Color fundus photograph
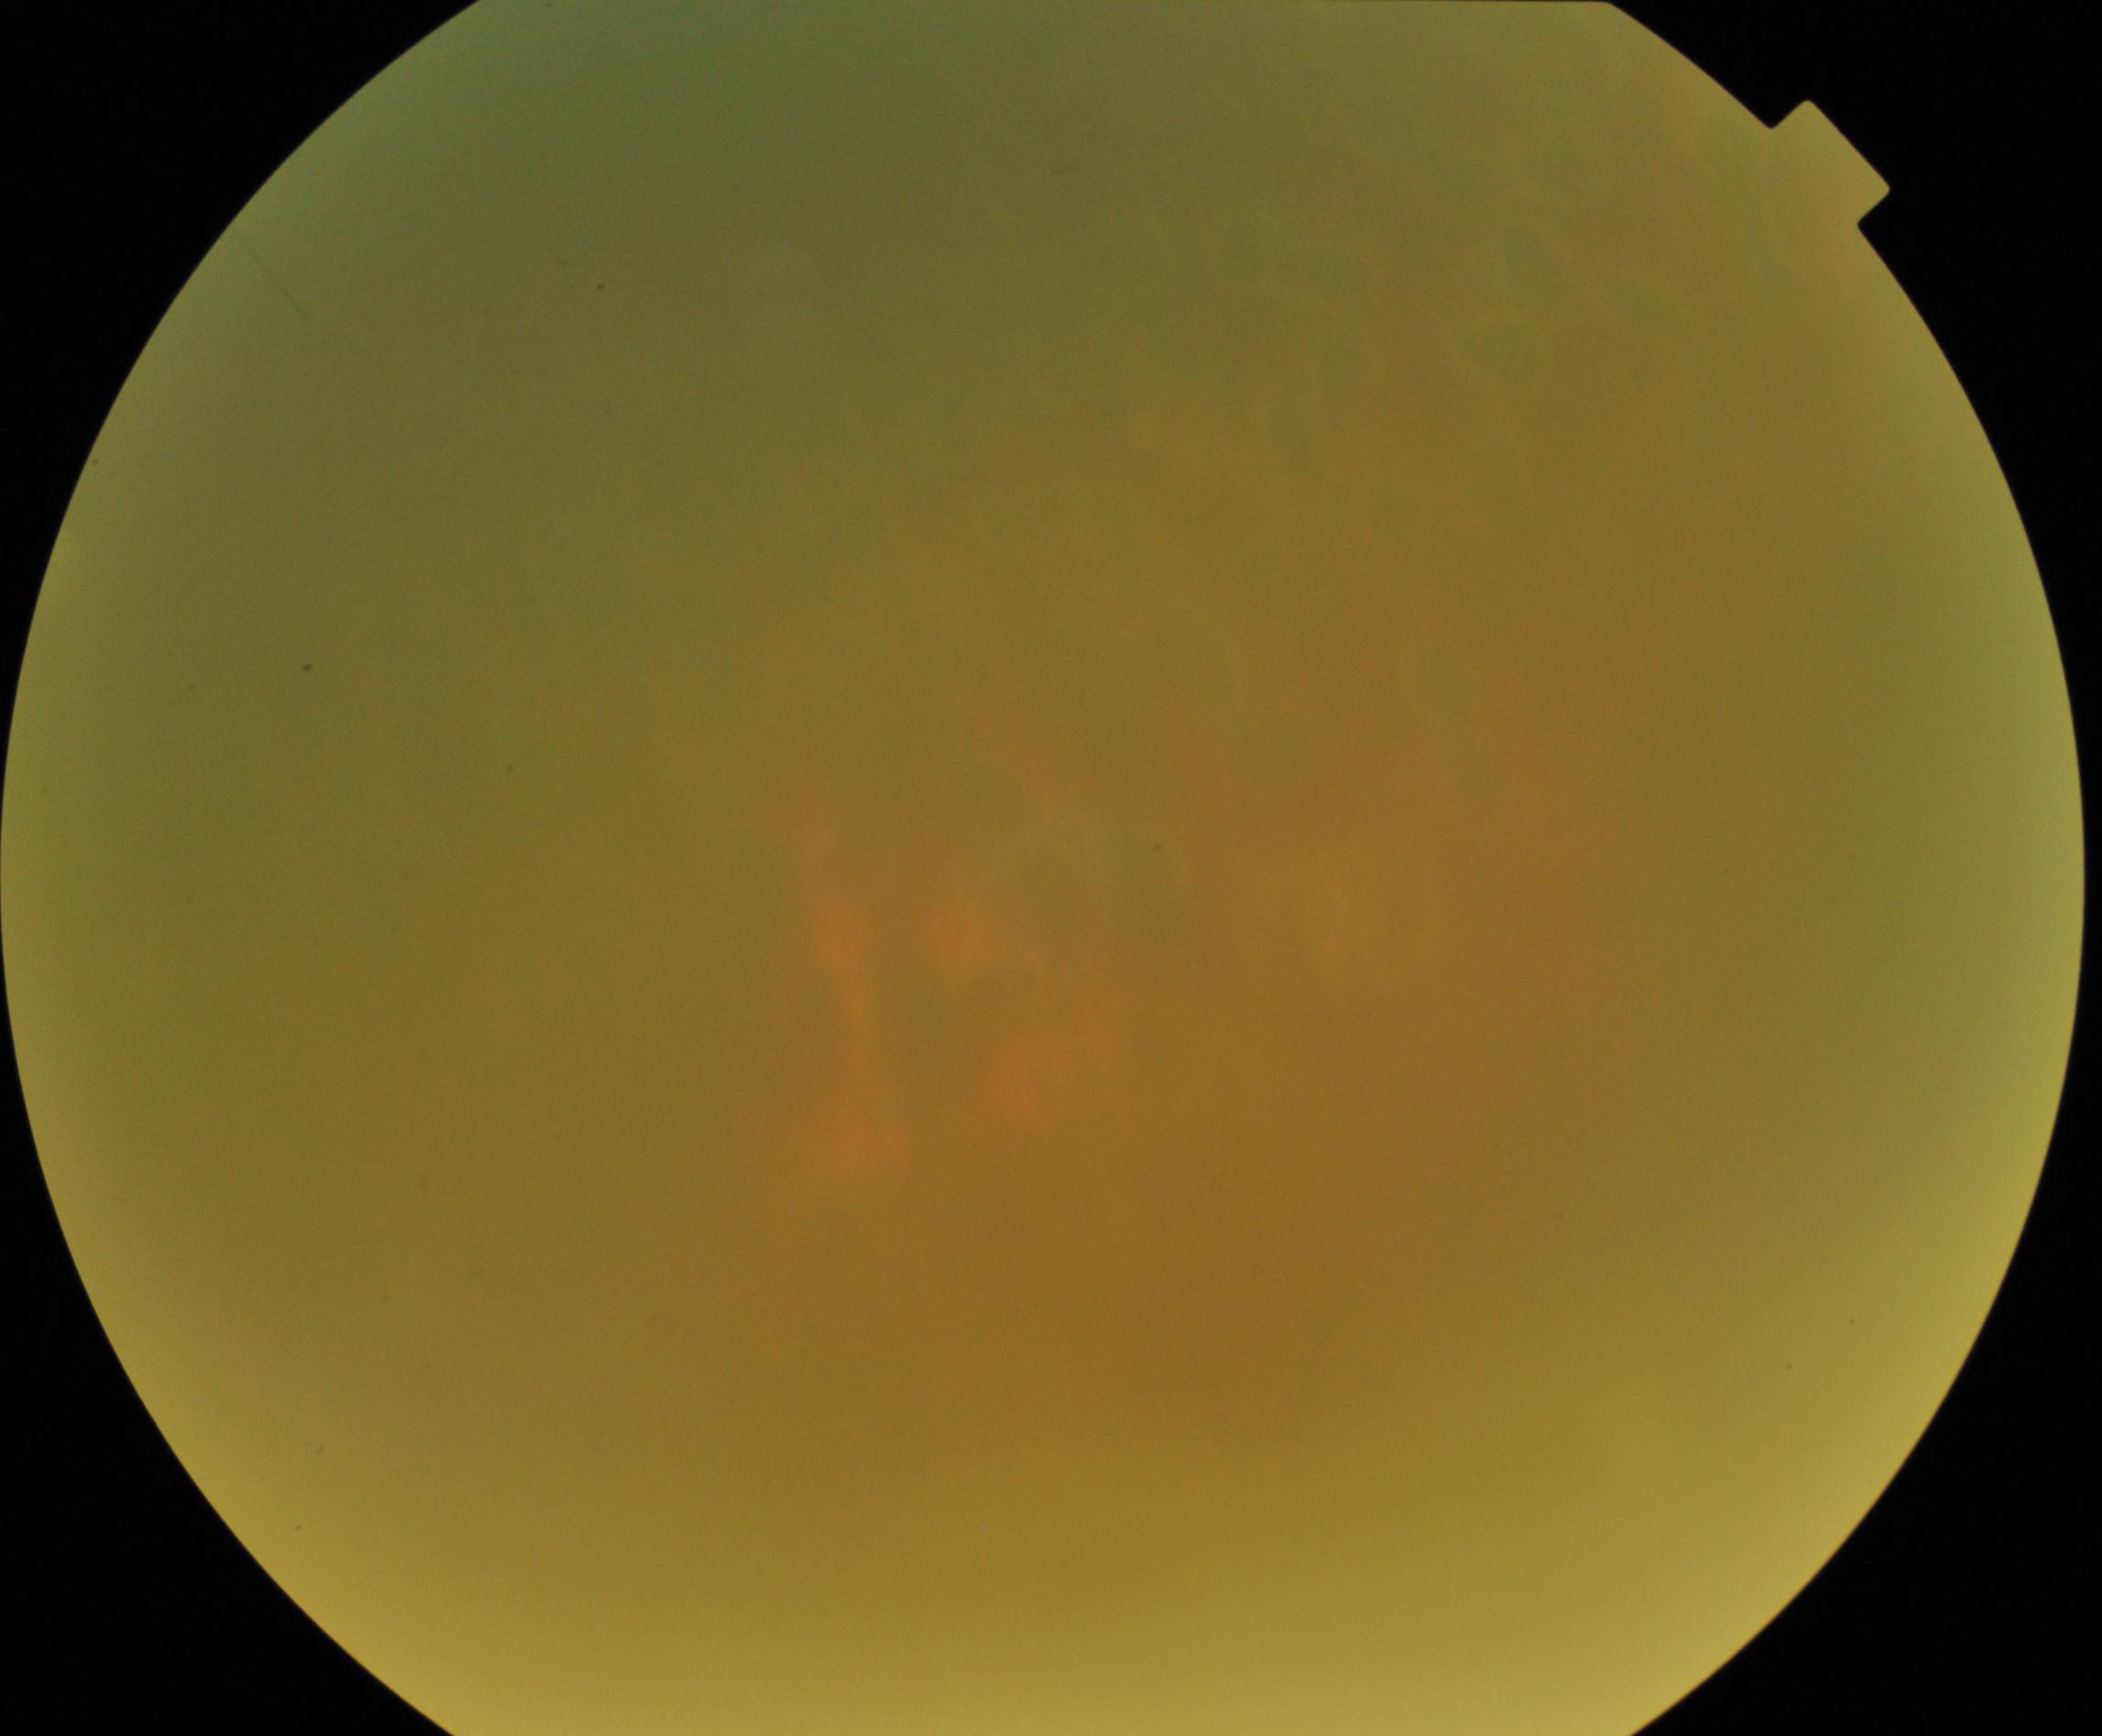

Image quality: poor, substantial obscuration of retinal landmarks. Proliferative diabetic retinopathy: negative.